Pediatric wide-field fundus photograph — 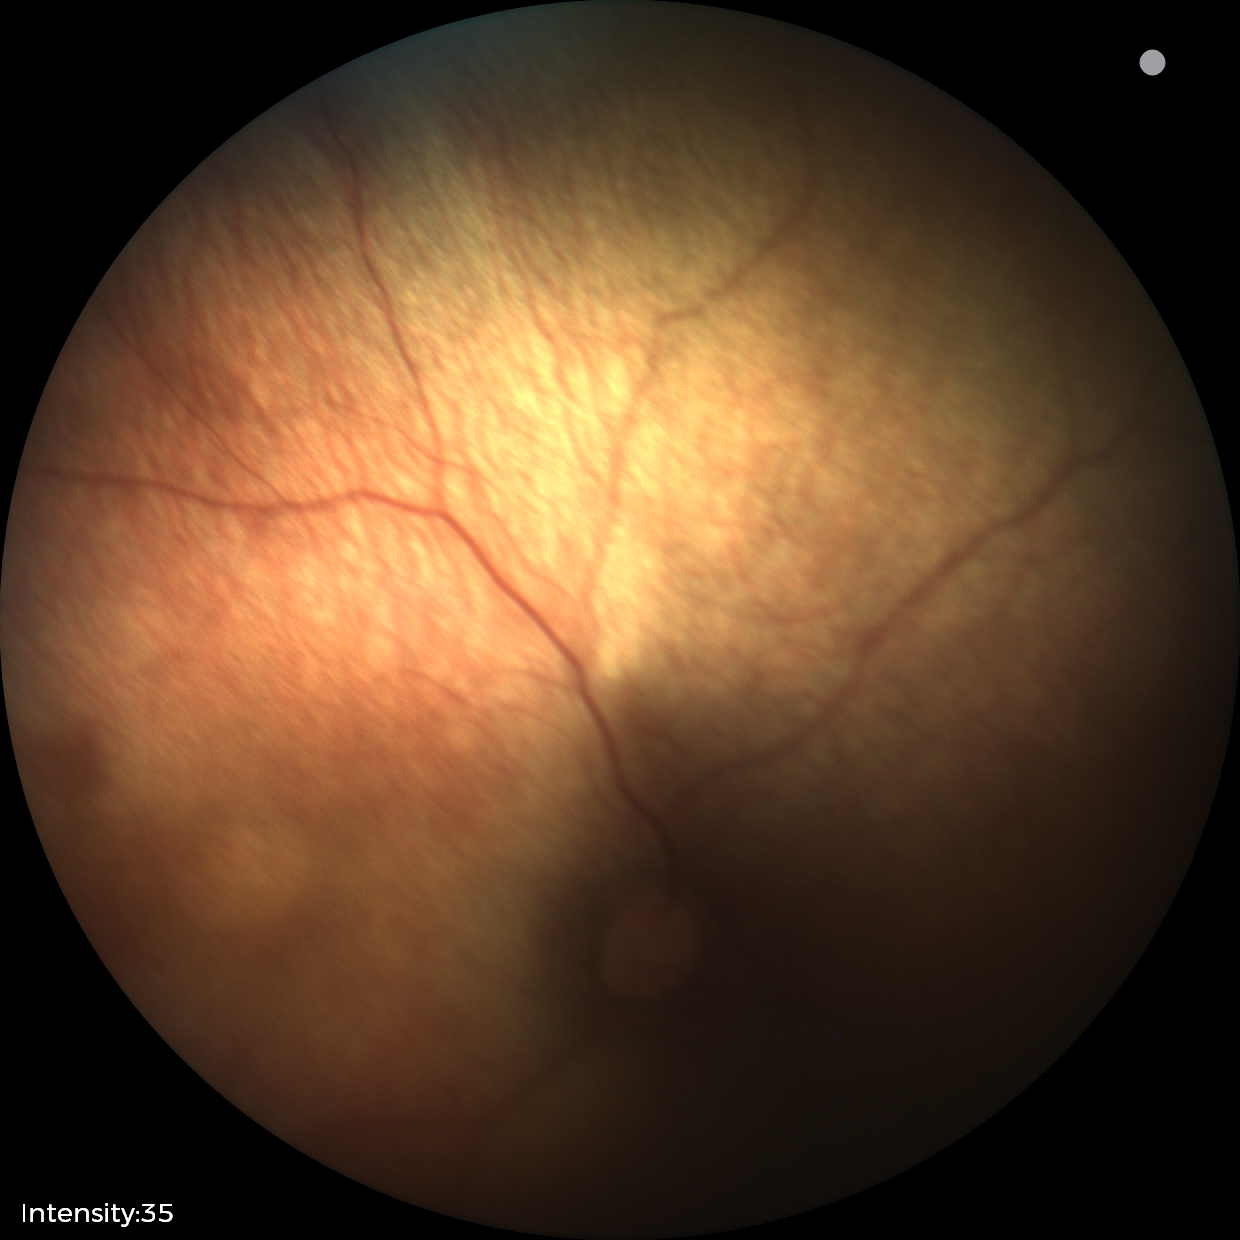 No retinal pathology identified on screening.